Retinal fundus photograph: 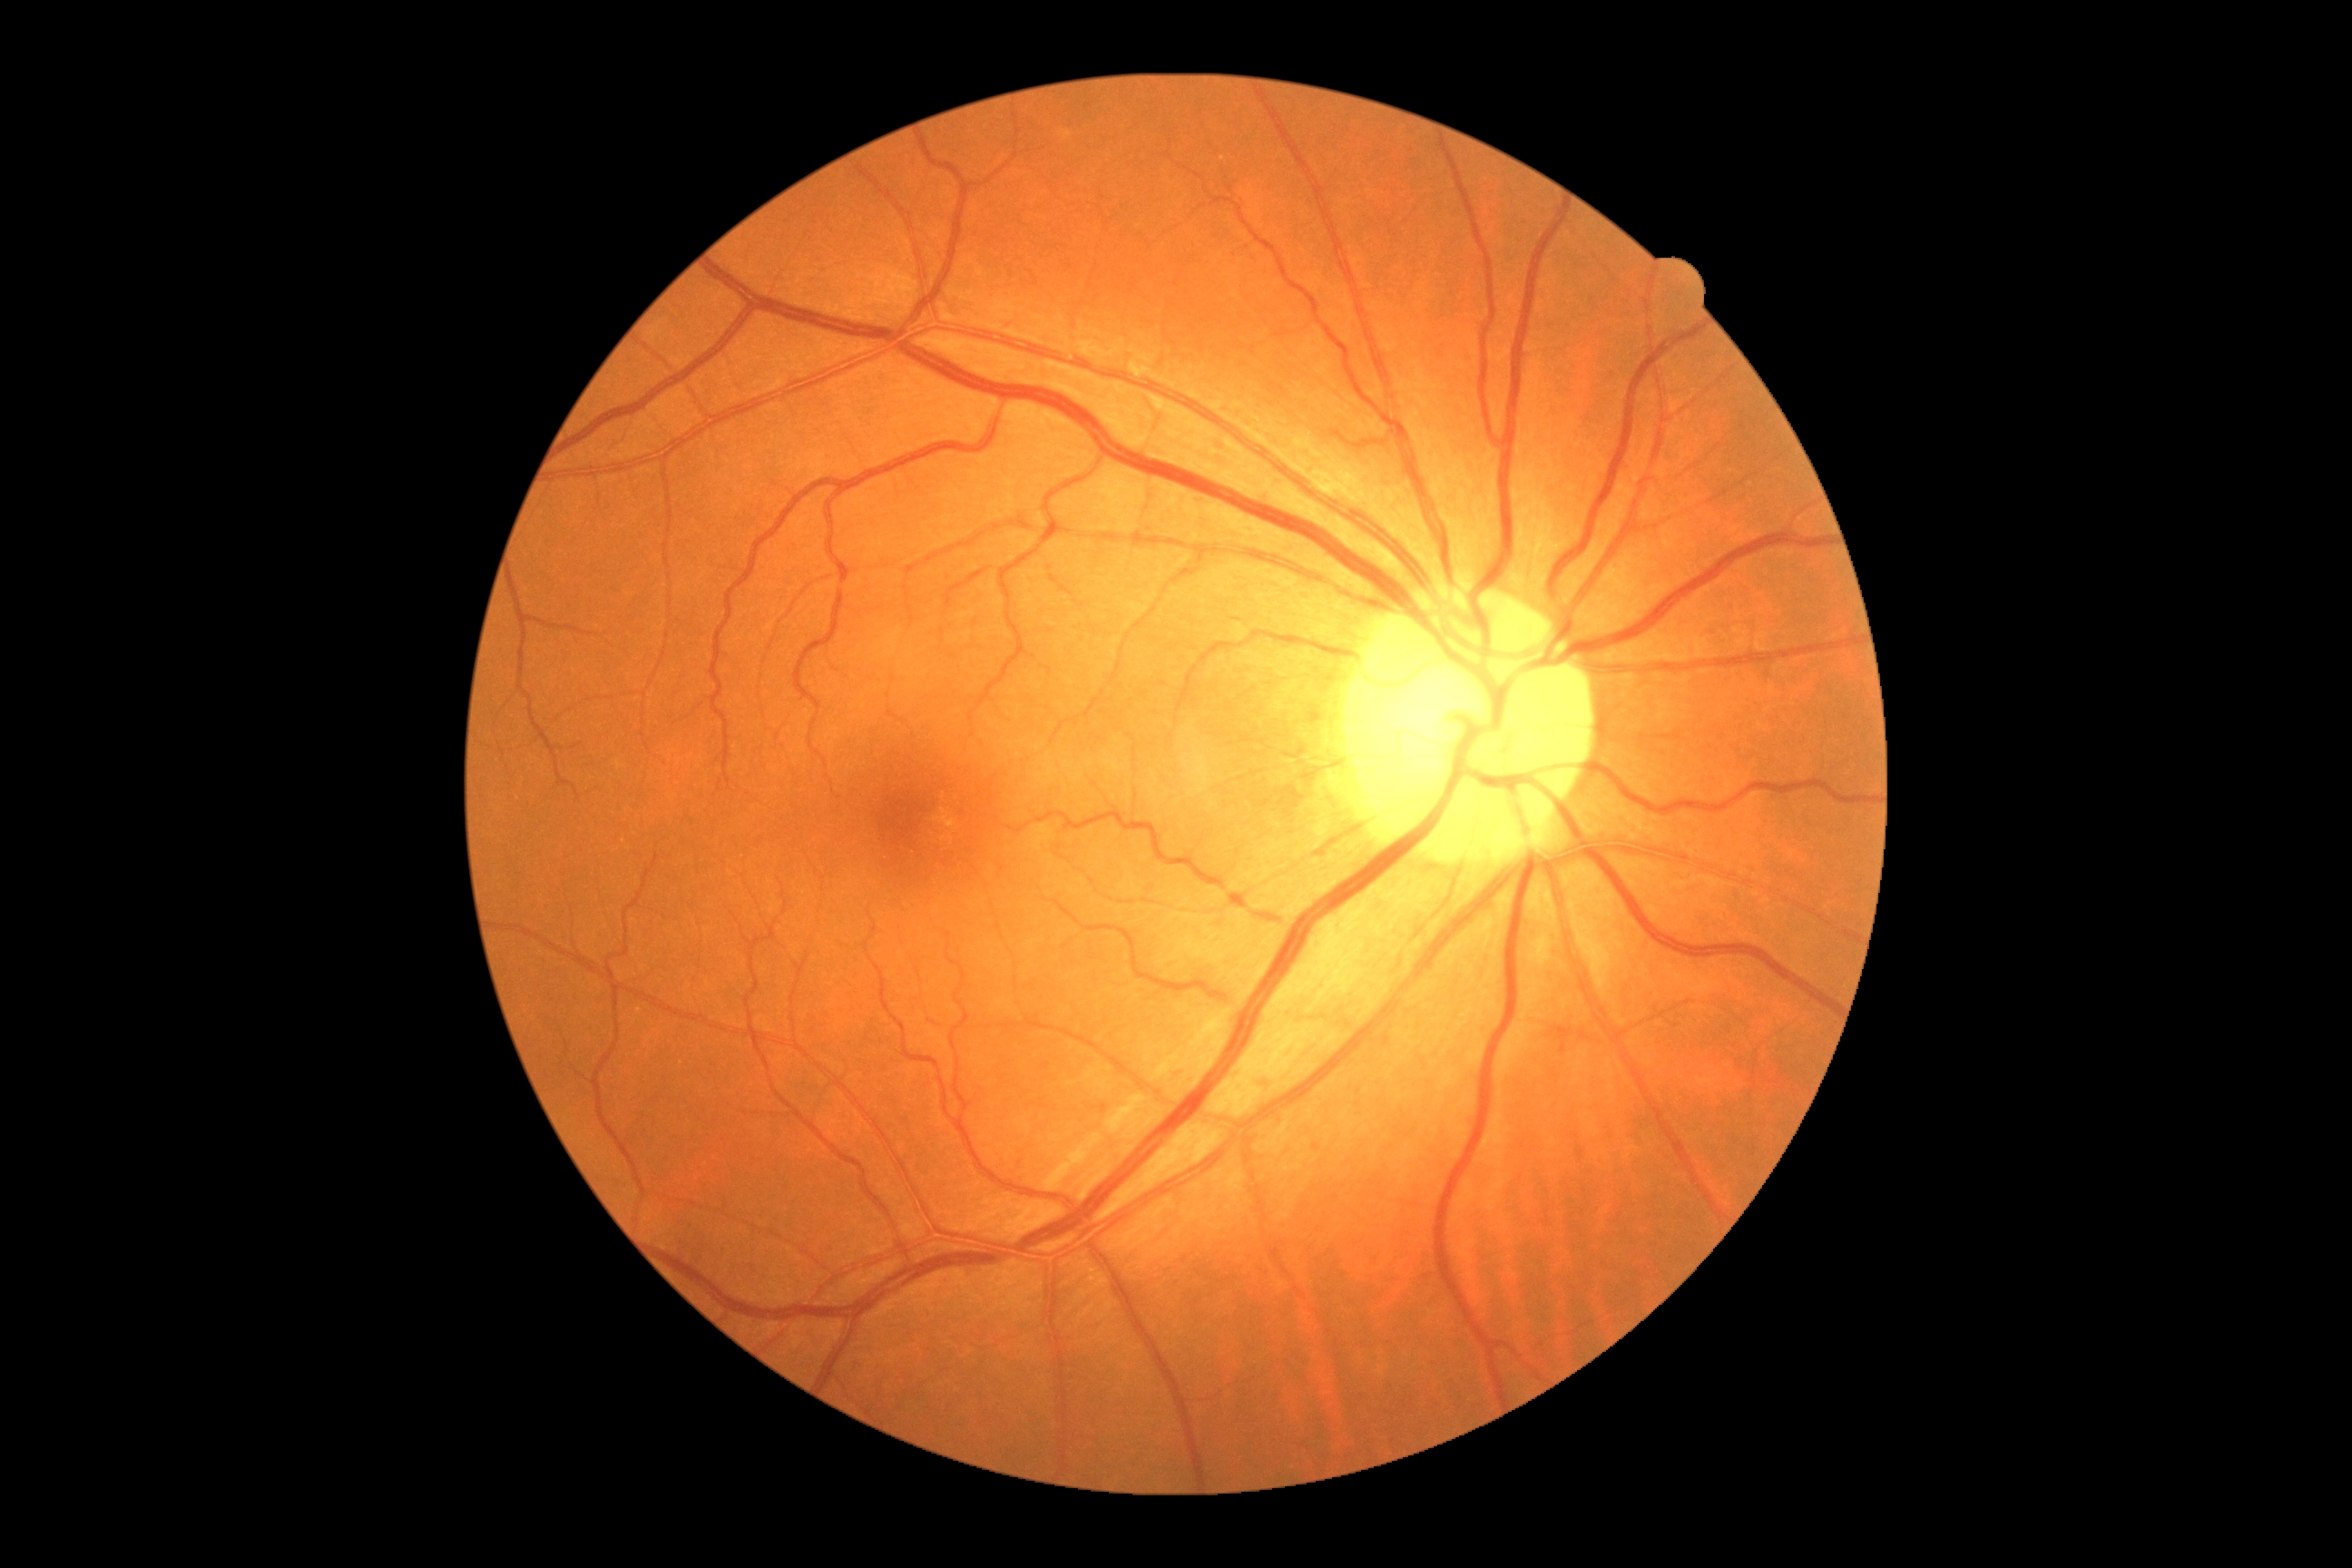

Diabetic retinopathy grade is 0/4 — no visible signs of diabetic retinopathy.